Color fundus image
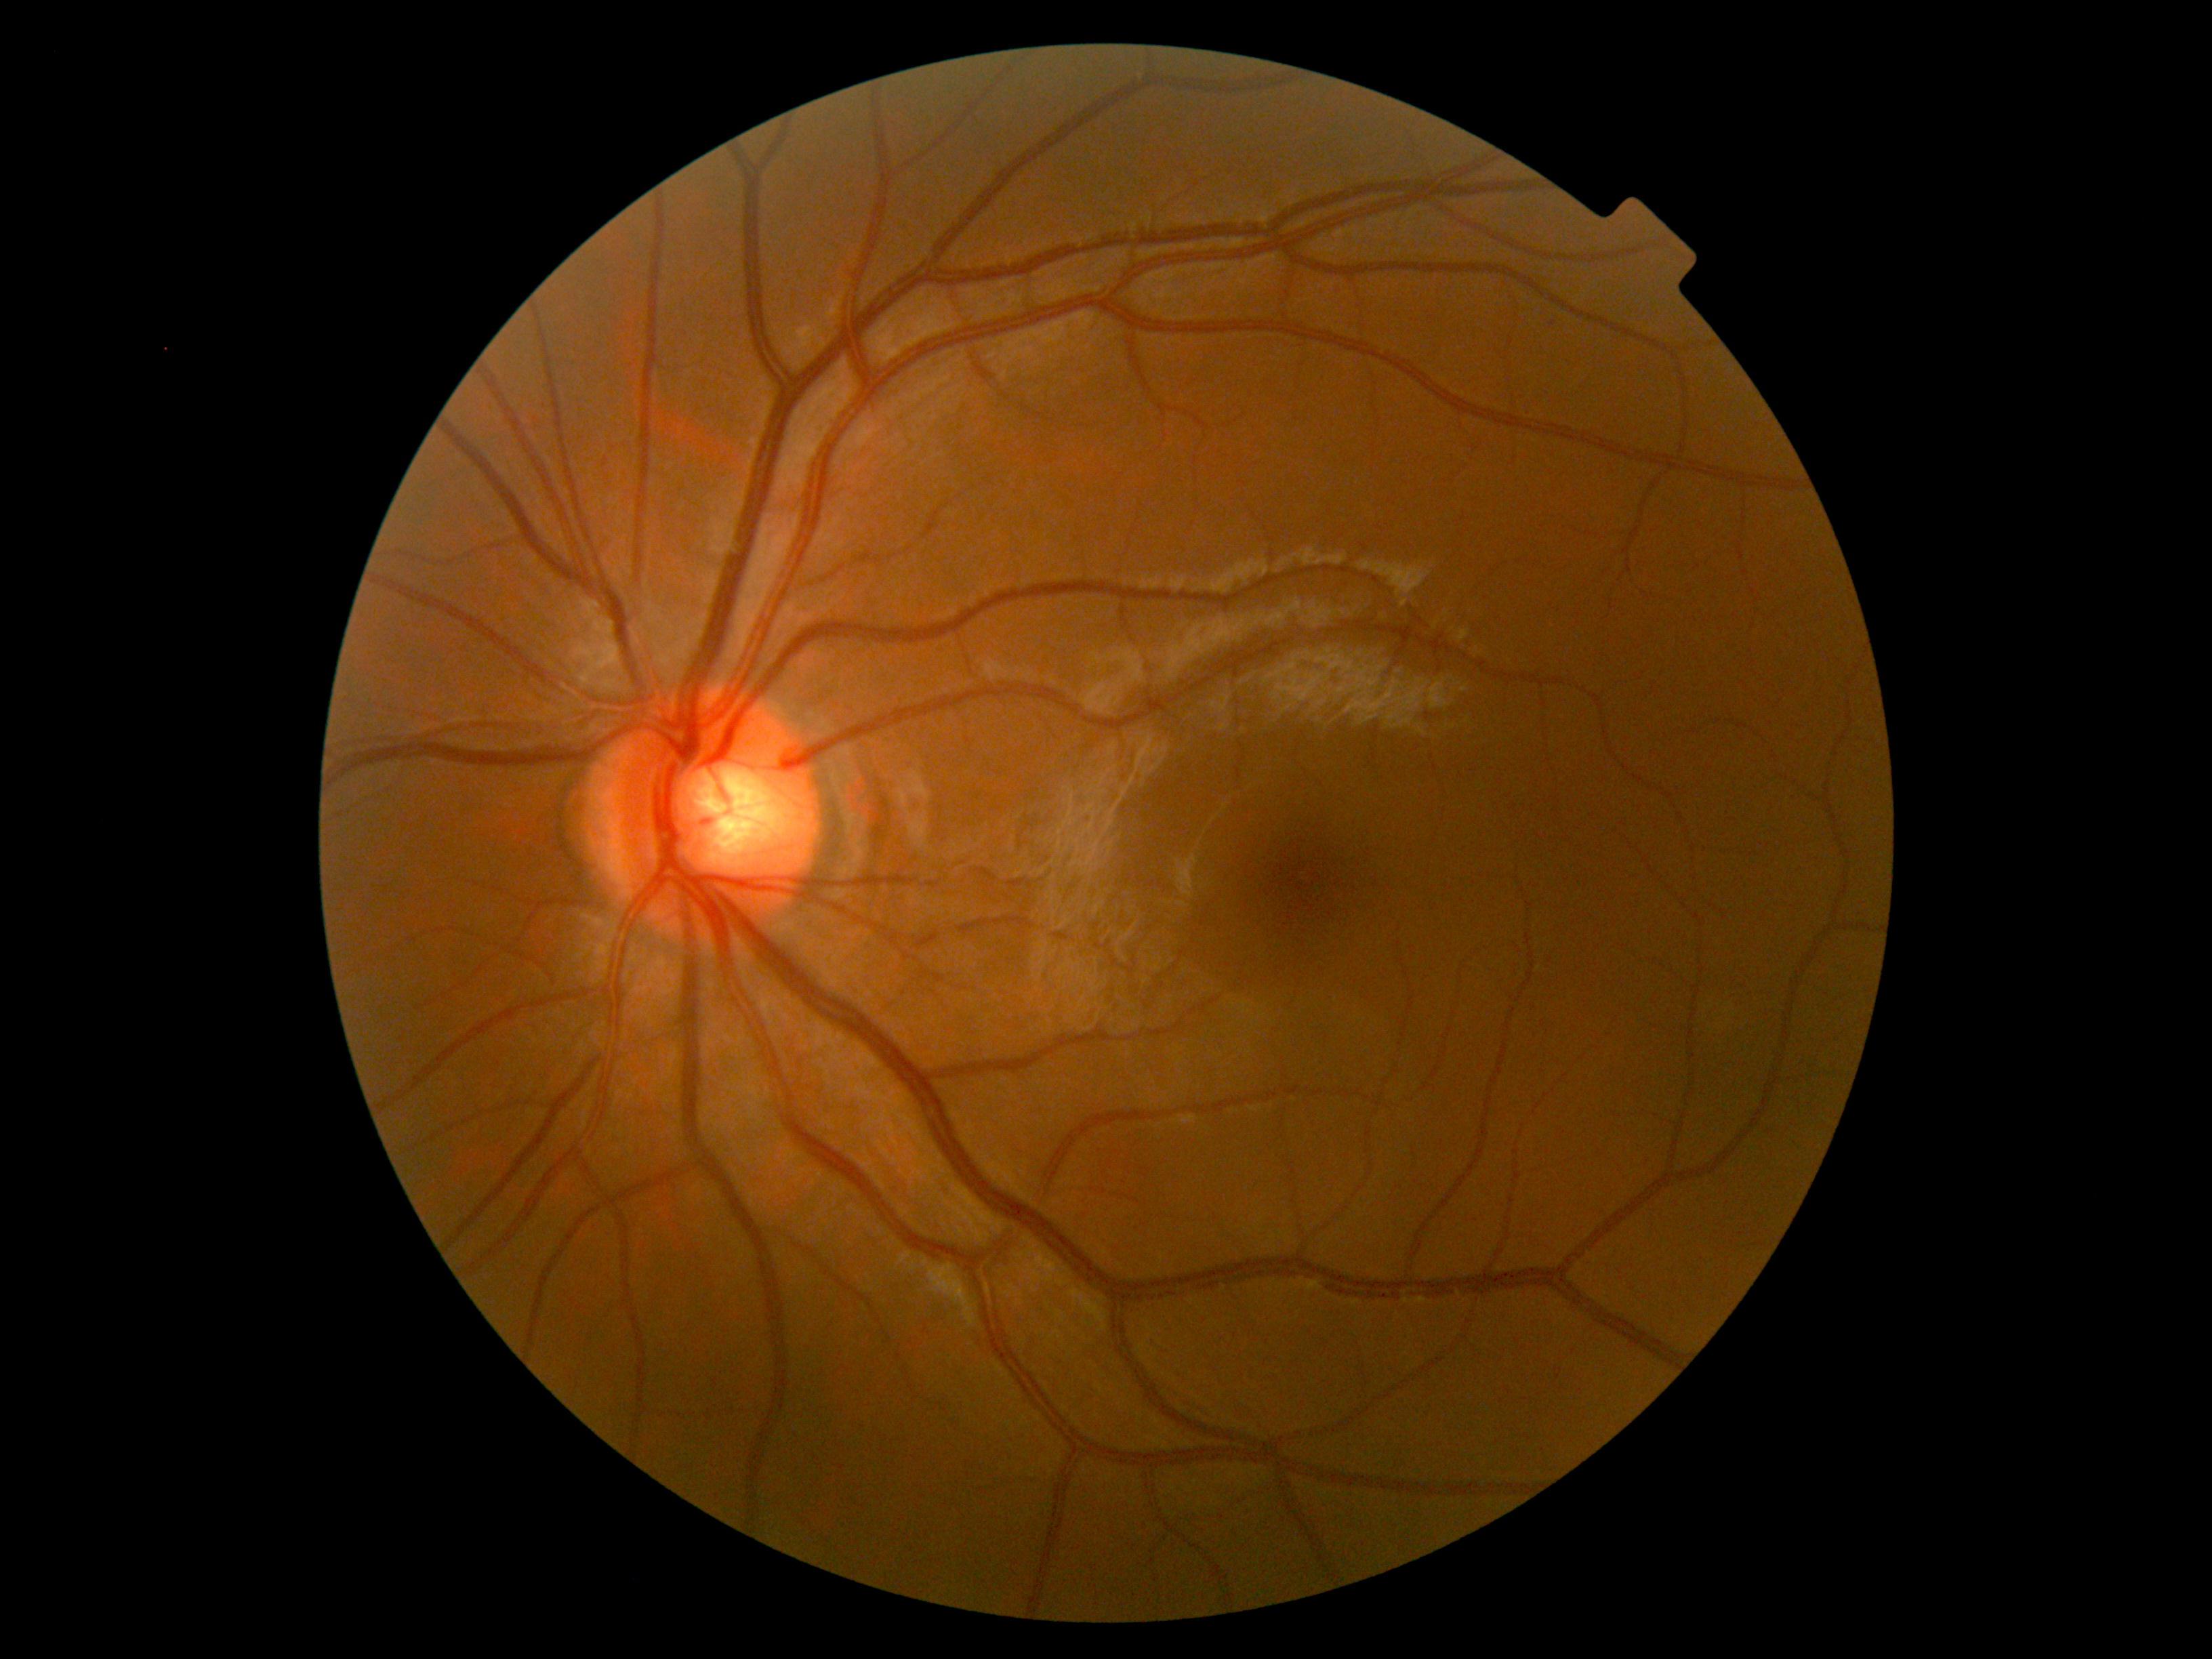 DR is no apparent retinopathy (grade 0).